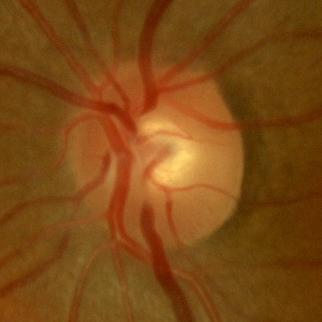 Findings consistent with no signs of glaucoma.